Davis DR grading: 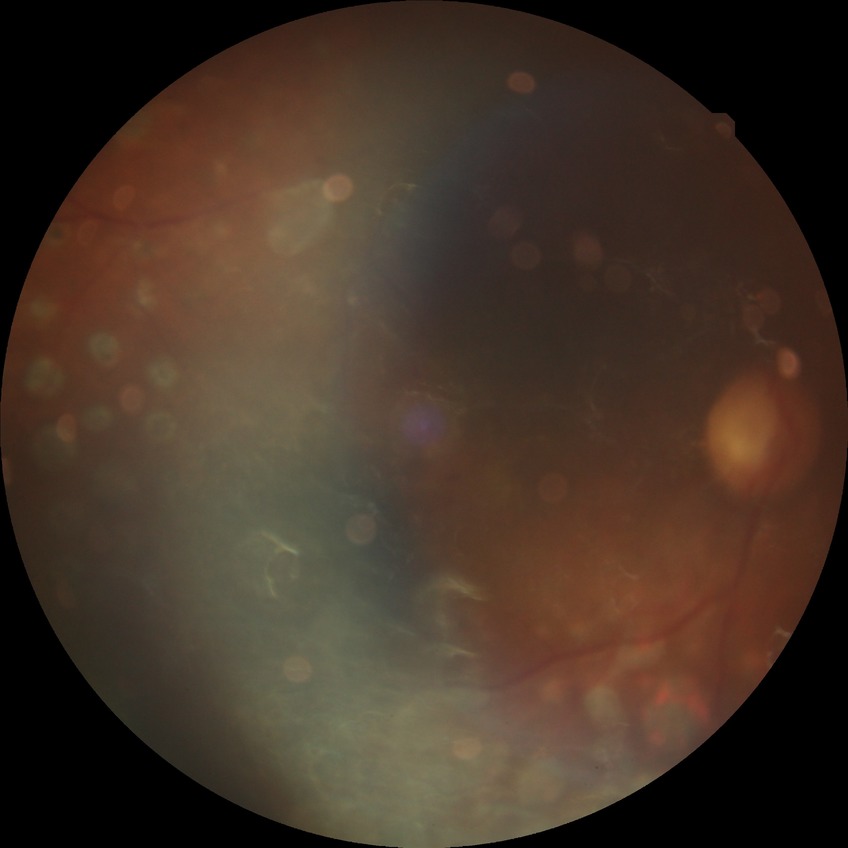
{
  "davis_grade": "proliferative diabetic retinopathy"
}